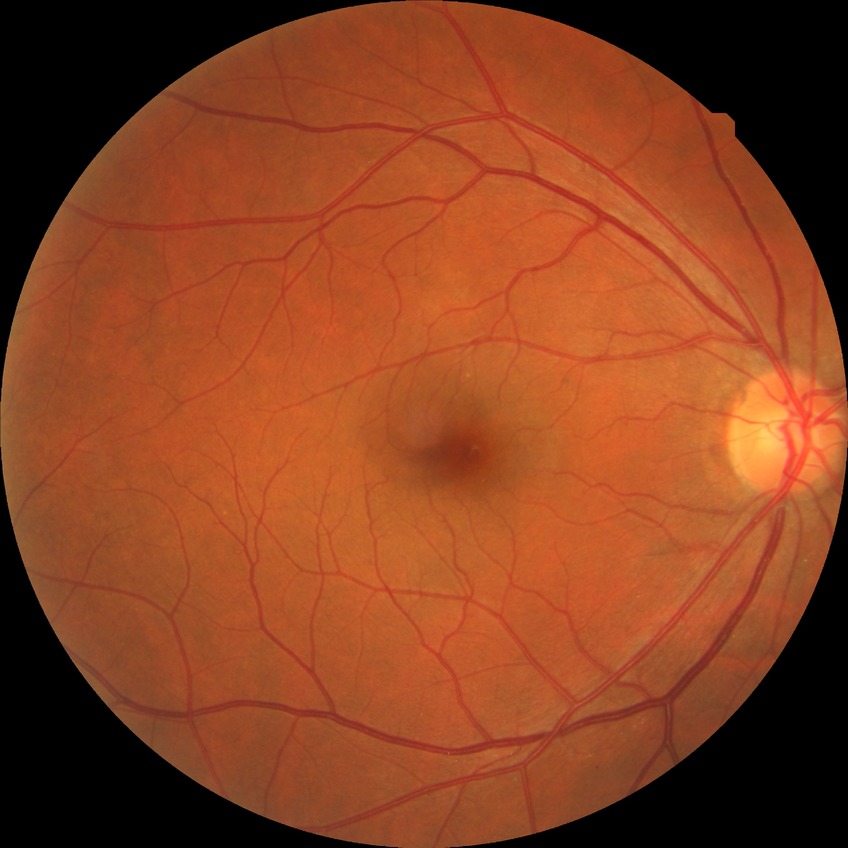
Diabetic retinopathy severity: no diabetic retinopathy.